2212x1659, color fundus photograph — 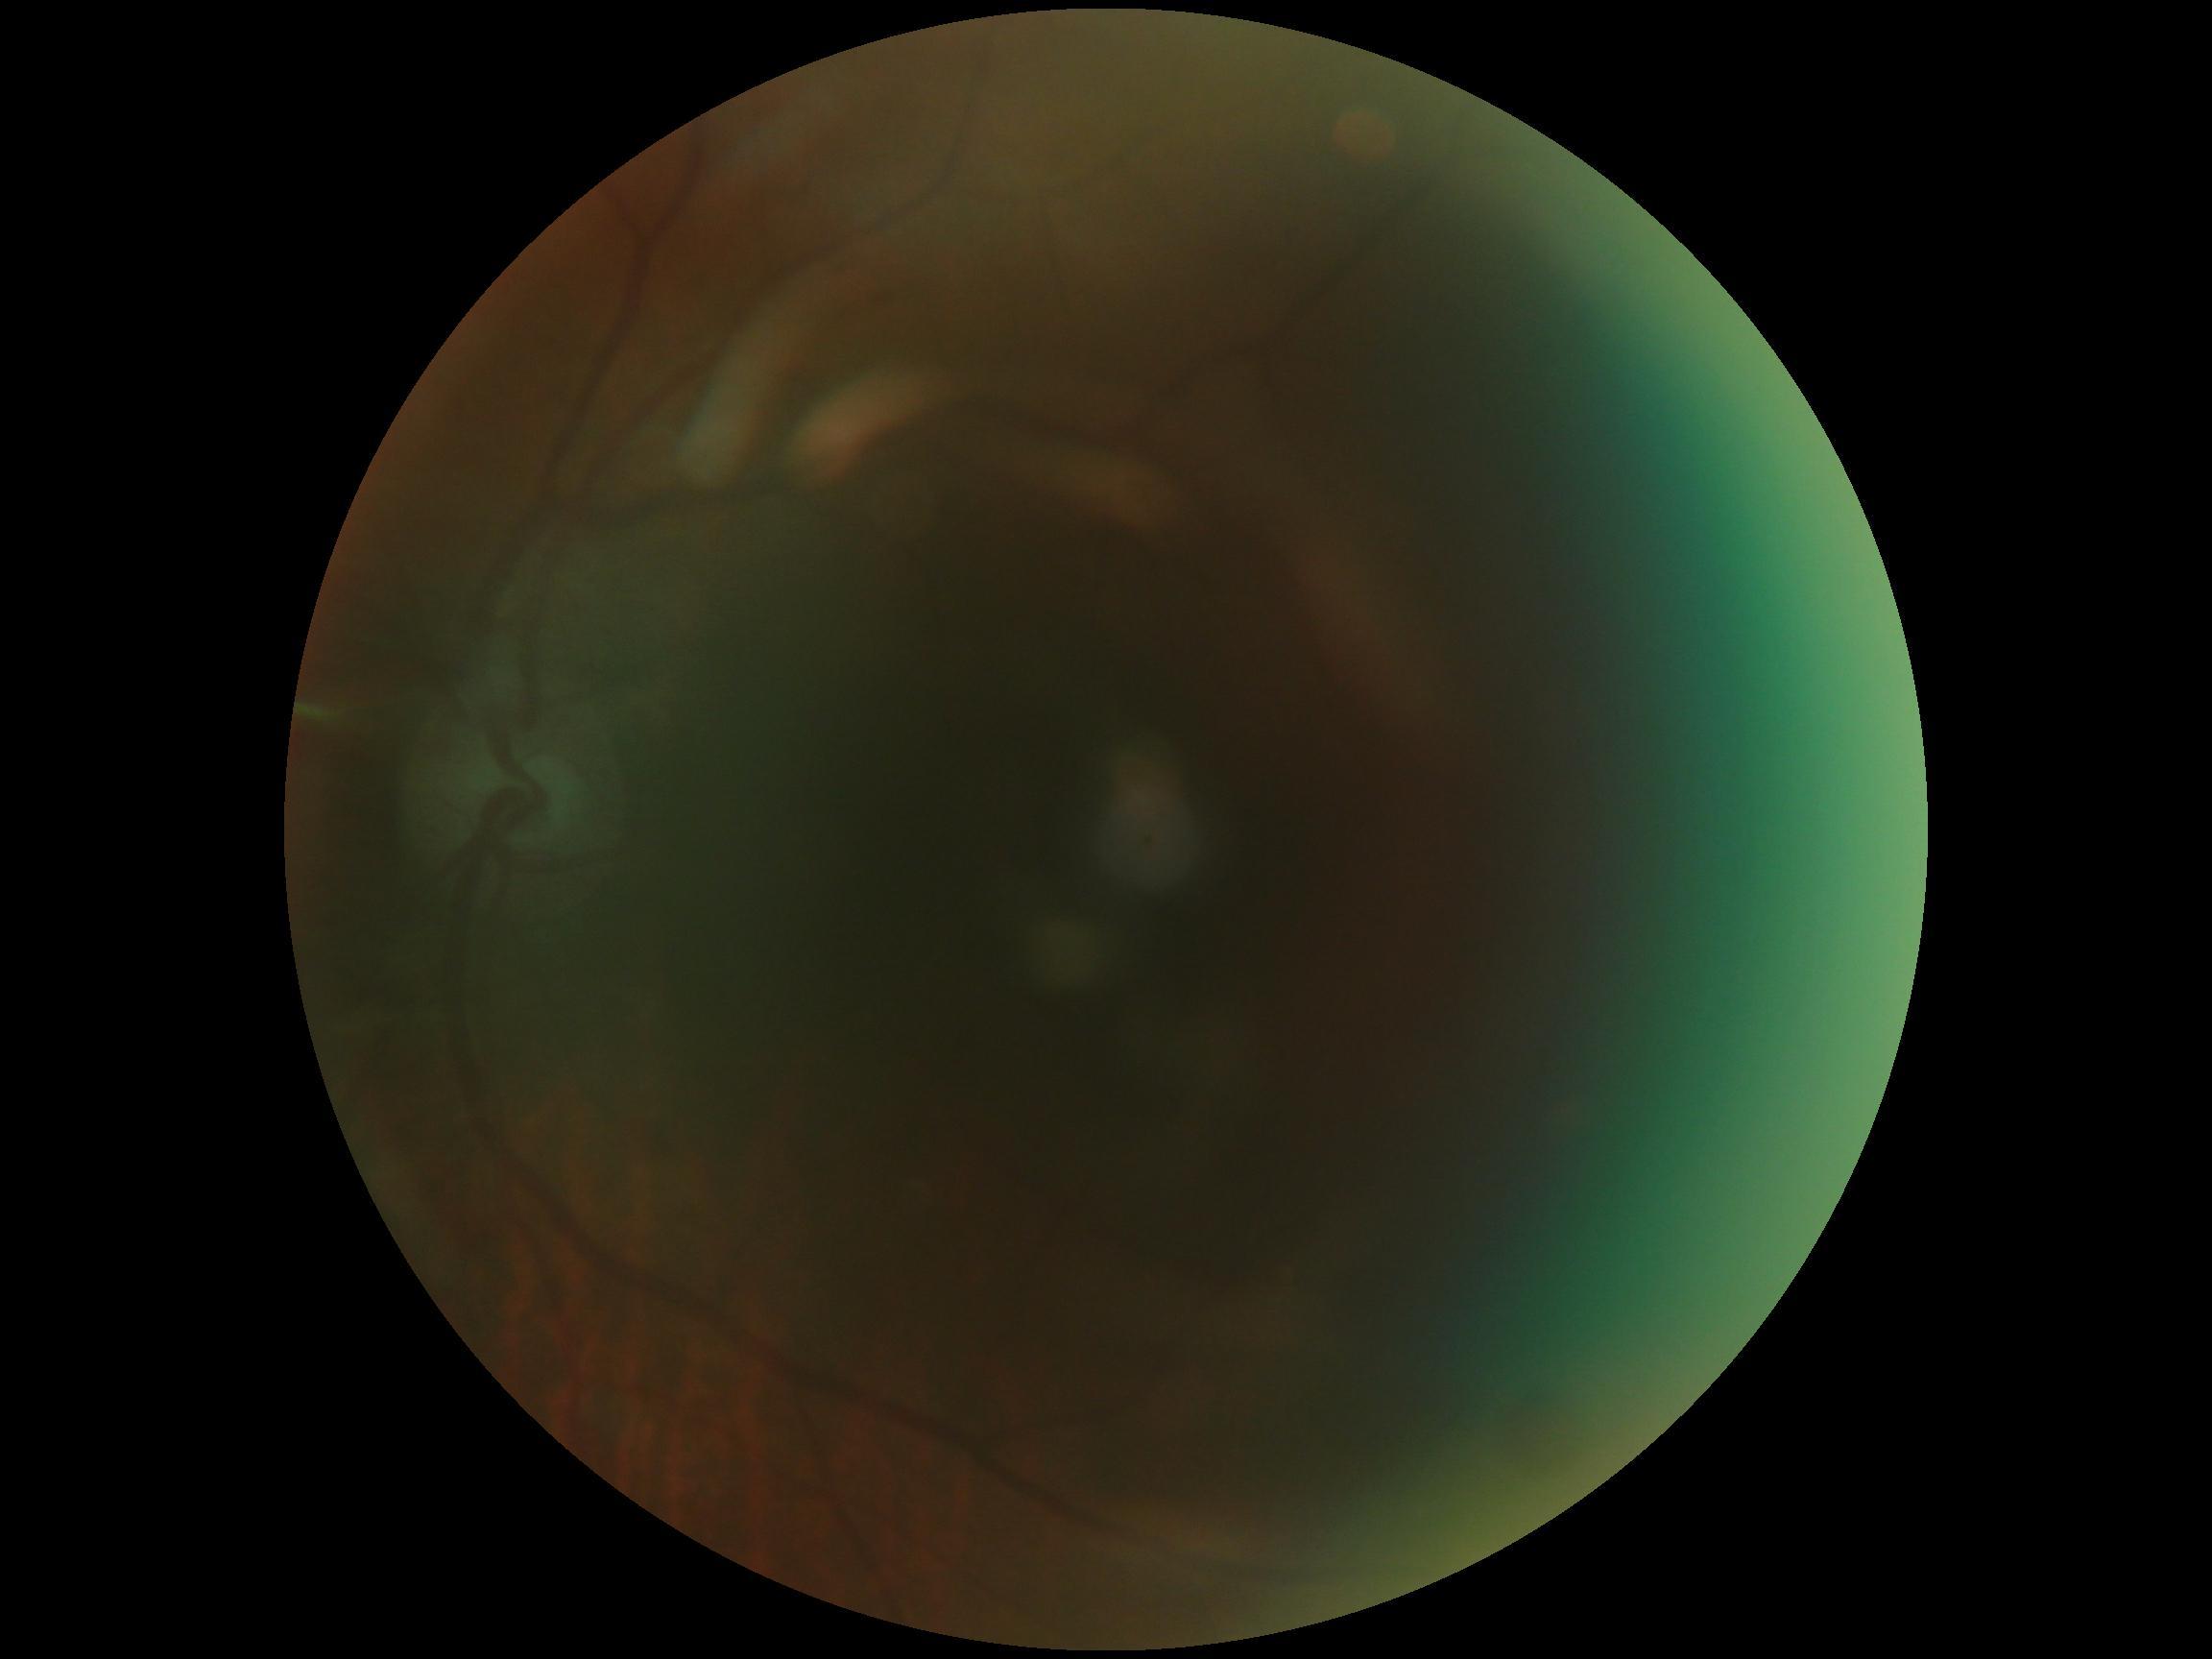
Findings:
• diabetic retinopathy severity: ungradable